Cropped to the optic nerve head.
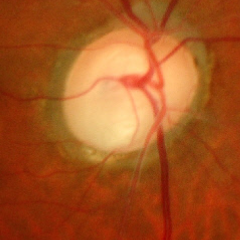 Glaucoma diagnosis = advanced glaucomatous optic neuropathy.